Nonmydriatic fundus photograph
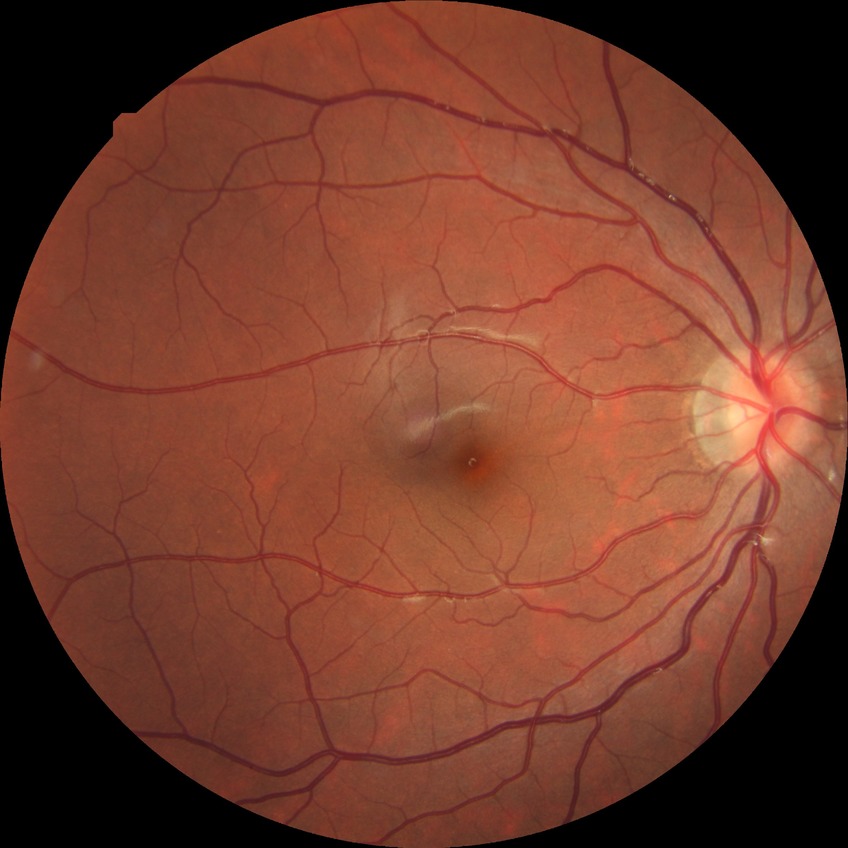 No apparent diabetic retinopathy.
DR stage is NDR.